Color fundus photograph.
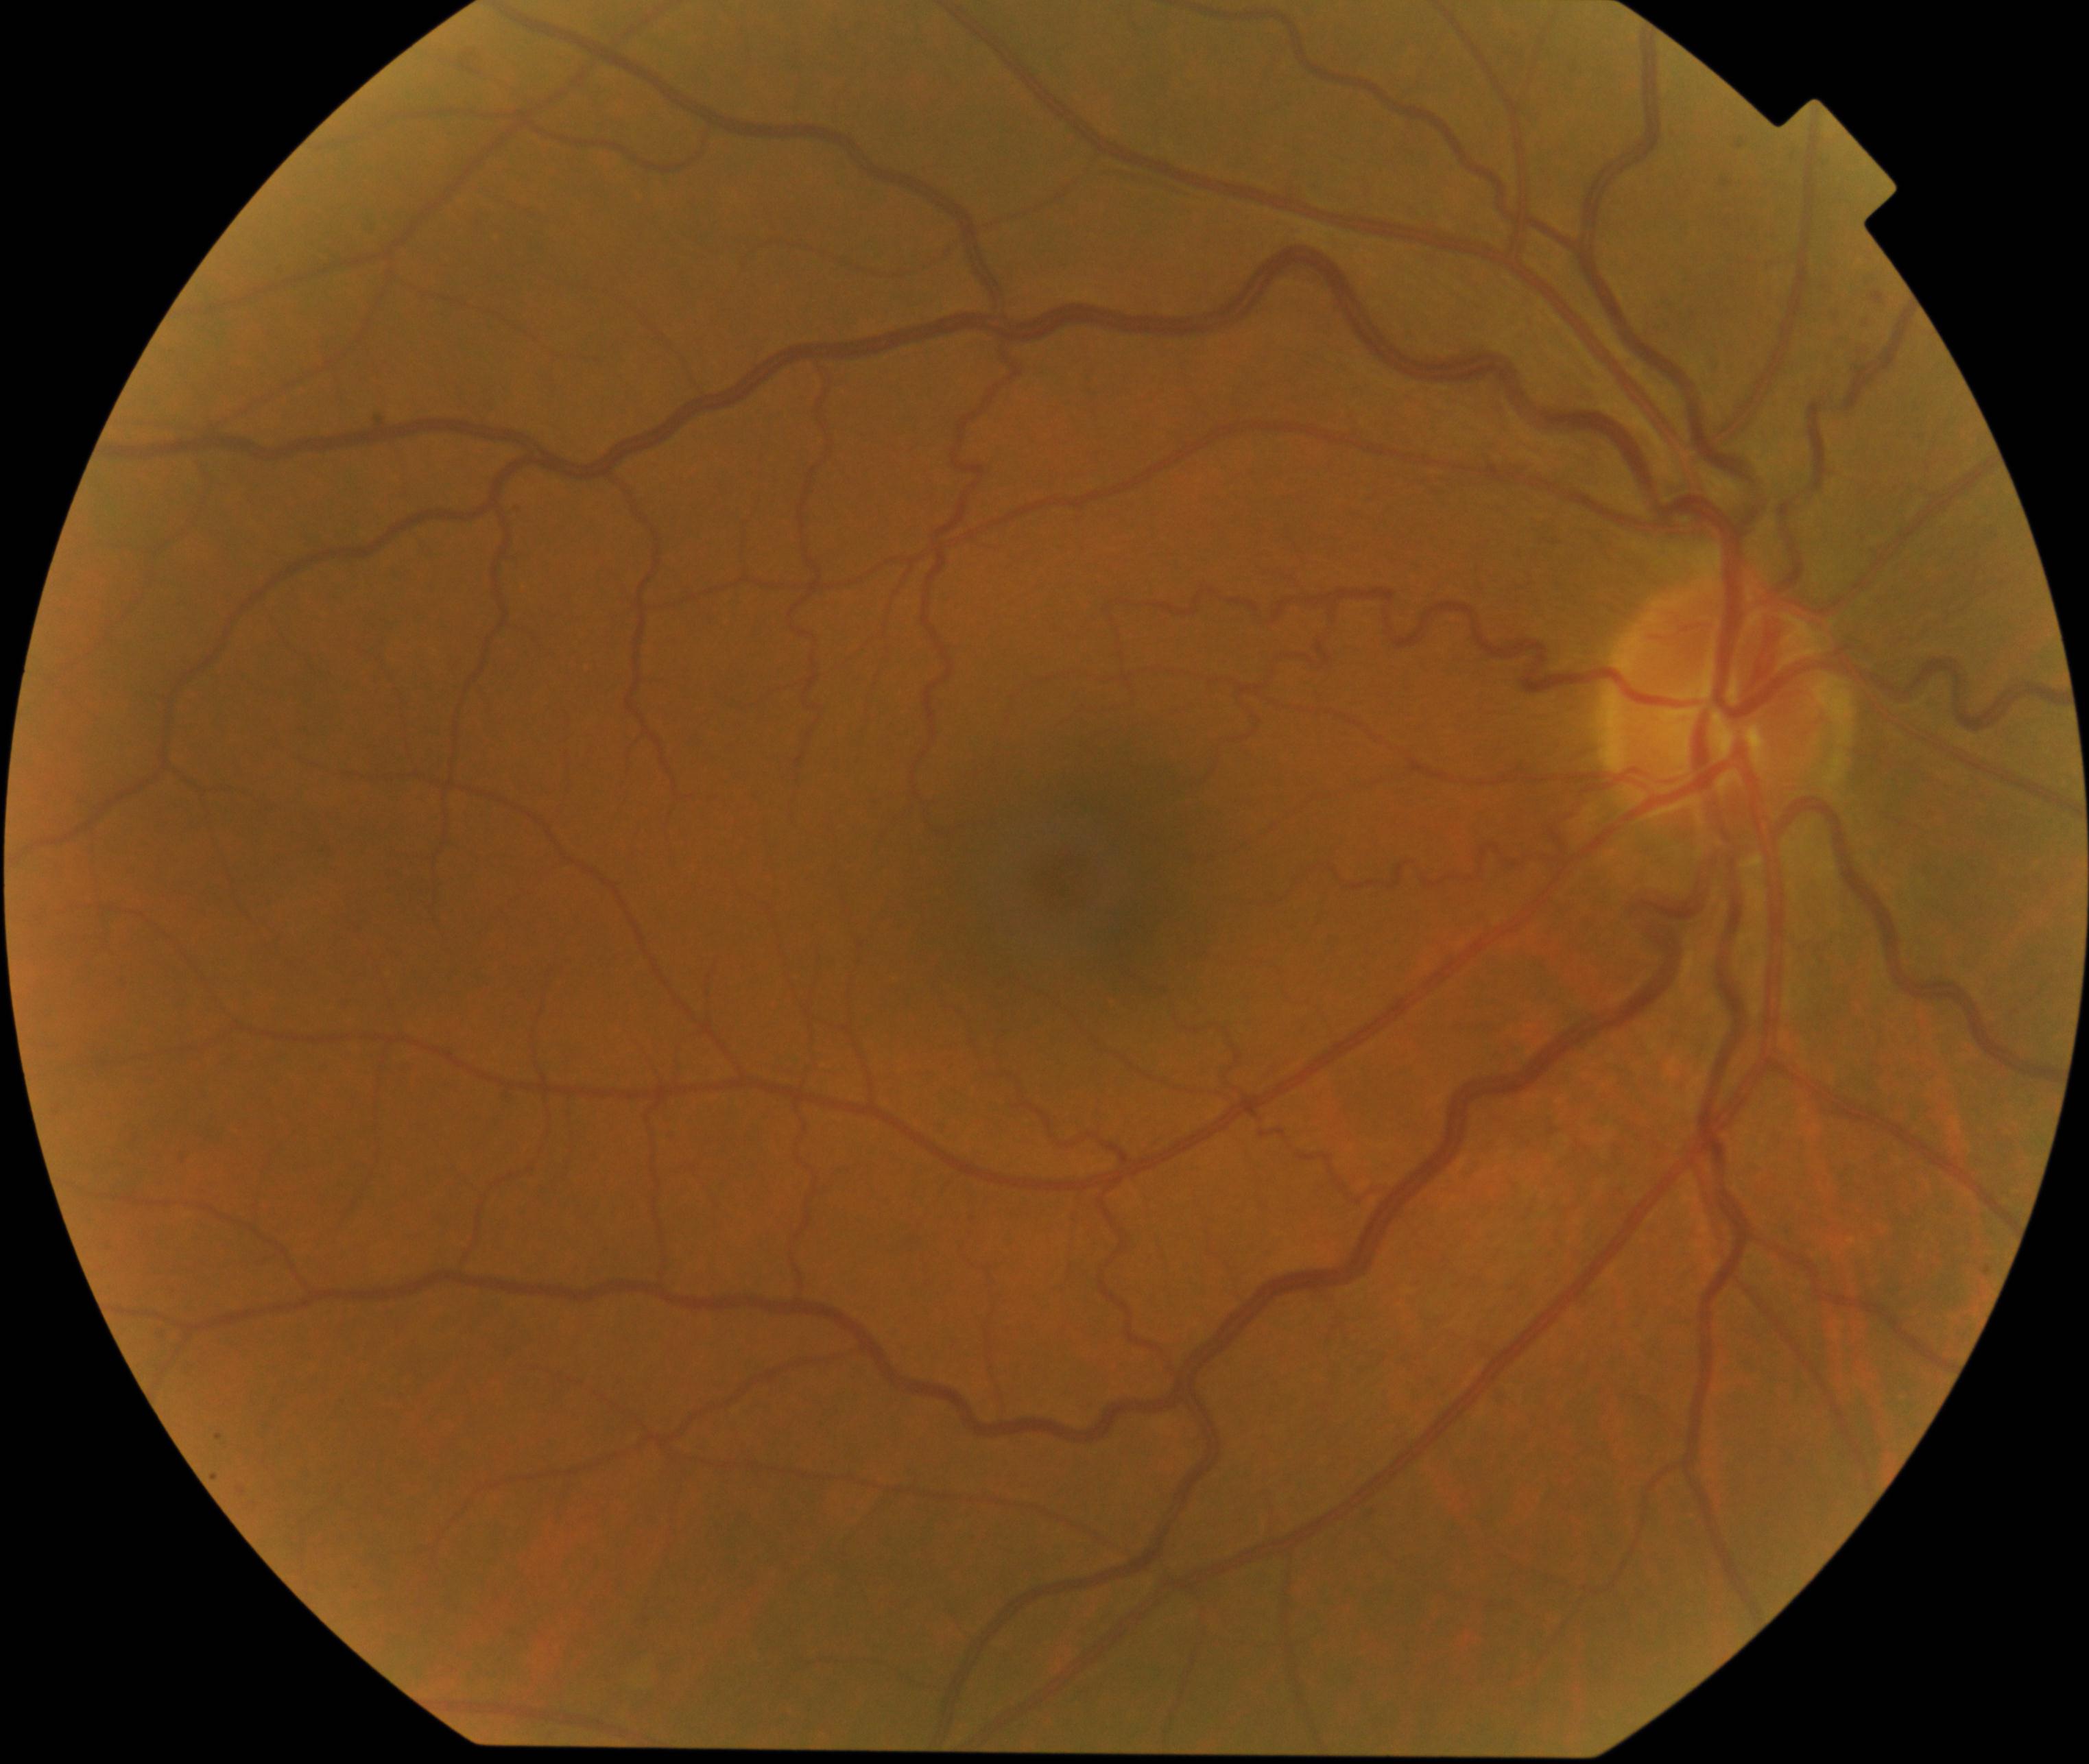

Findings: vessel tortuosity.